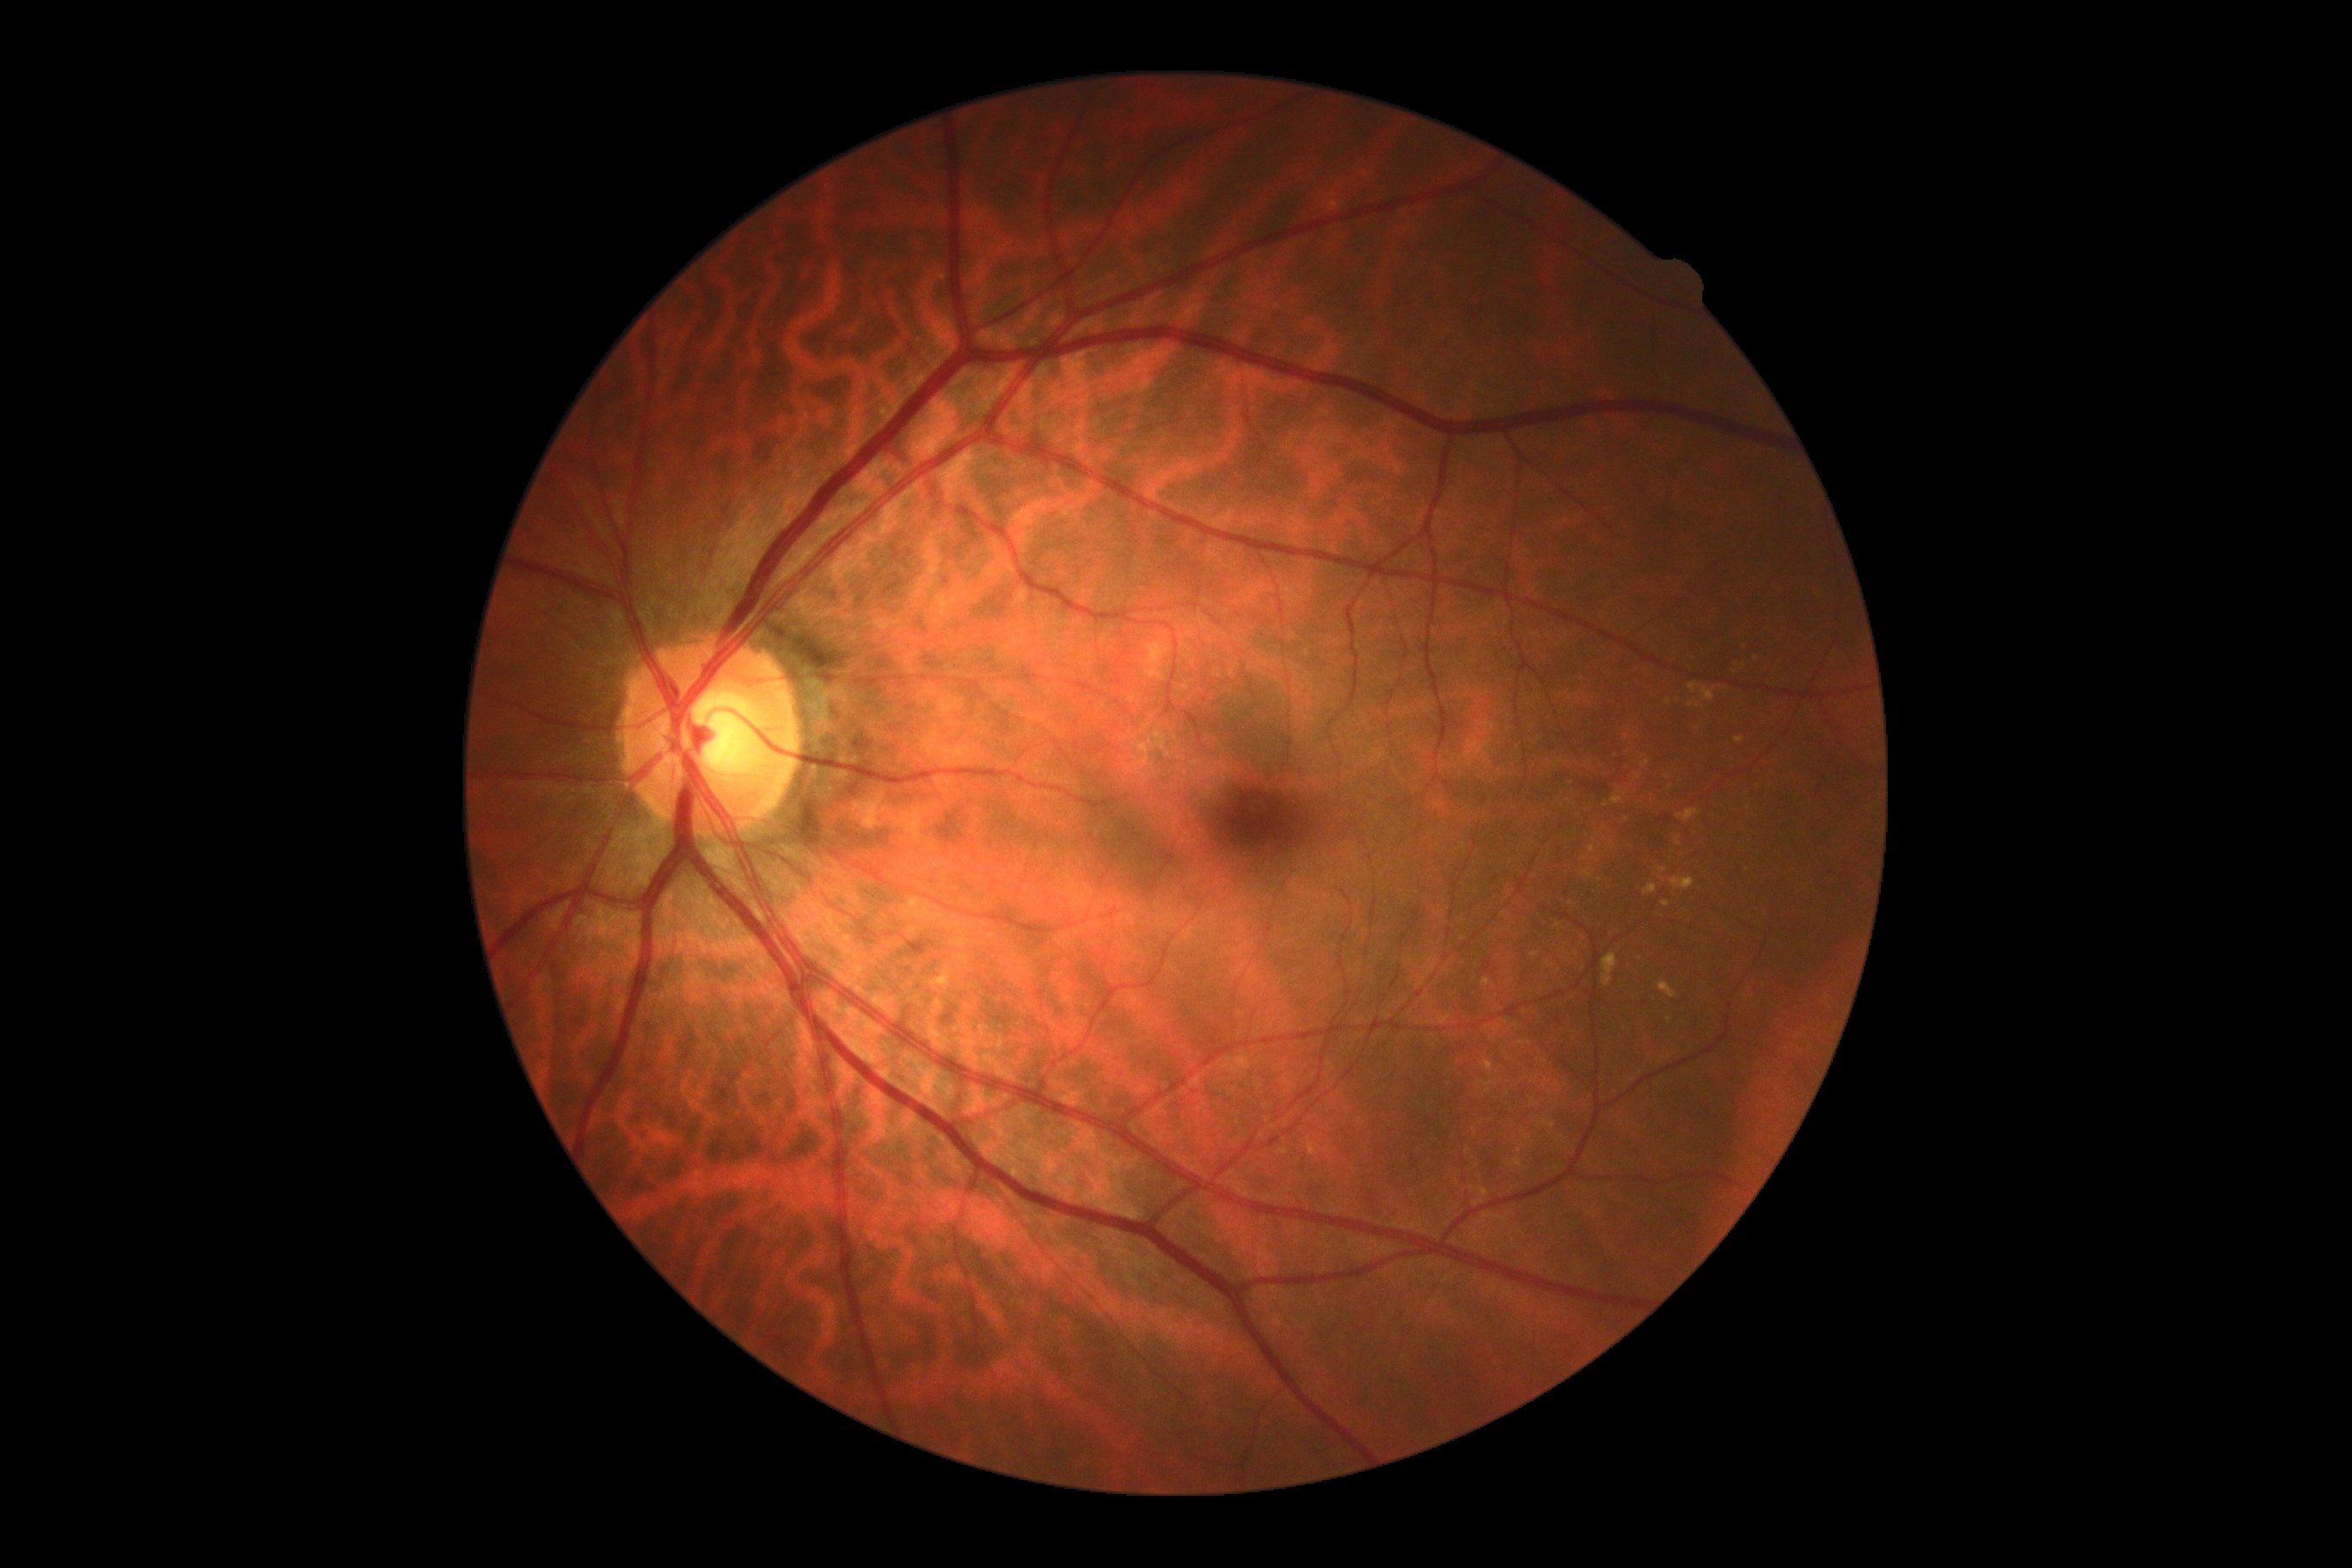 DR: no apparent retinopathy (grade 0).